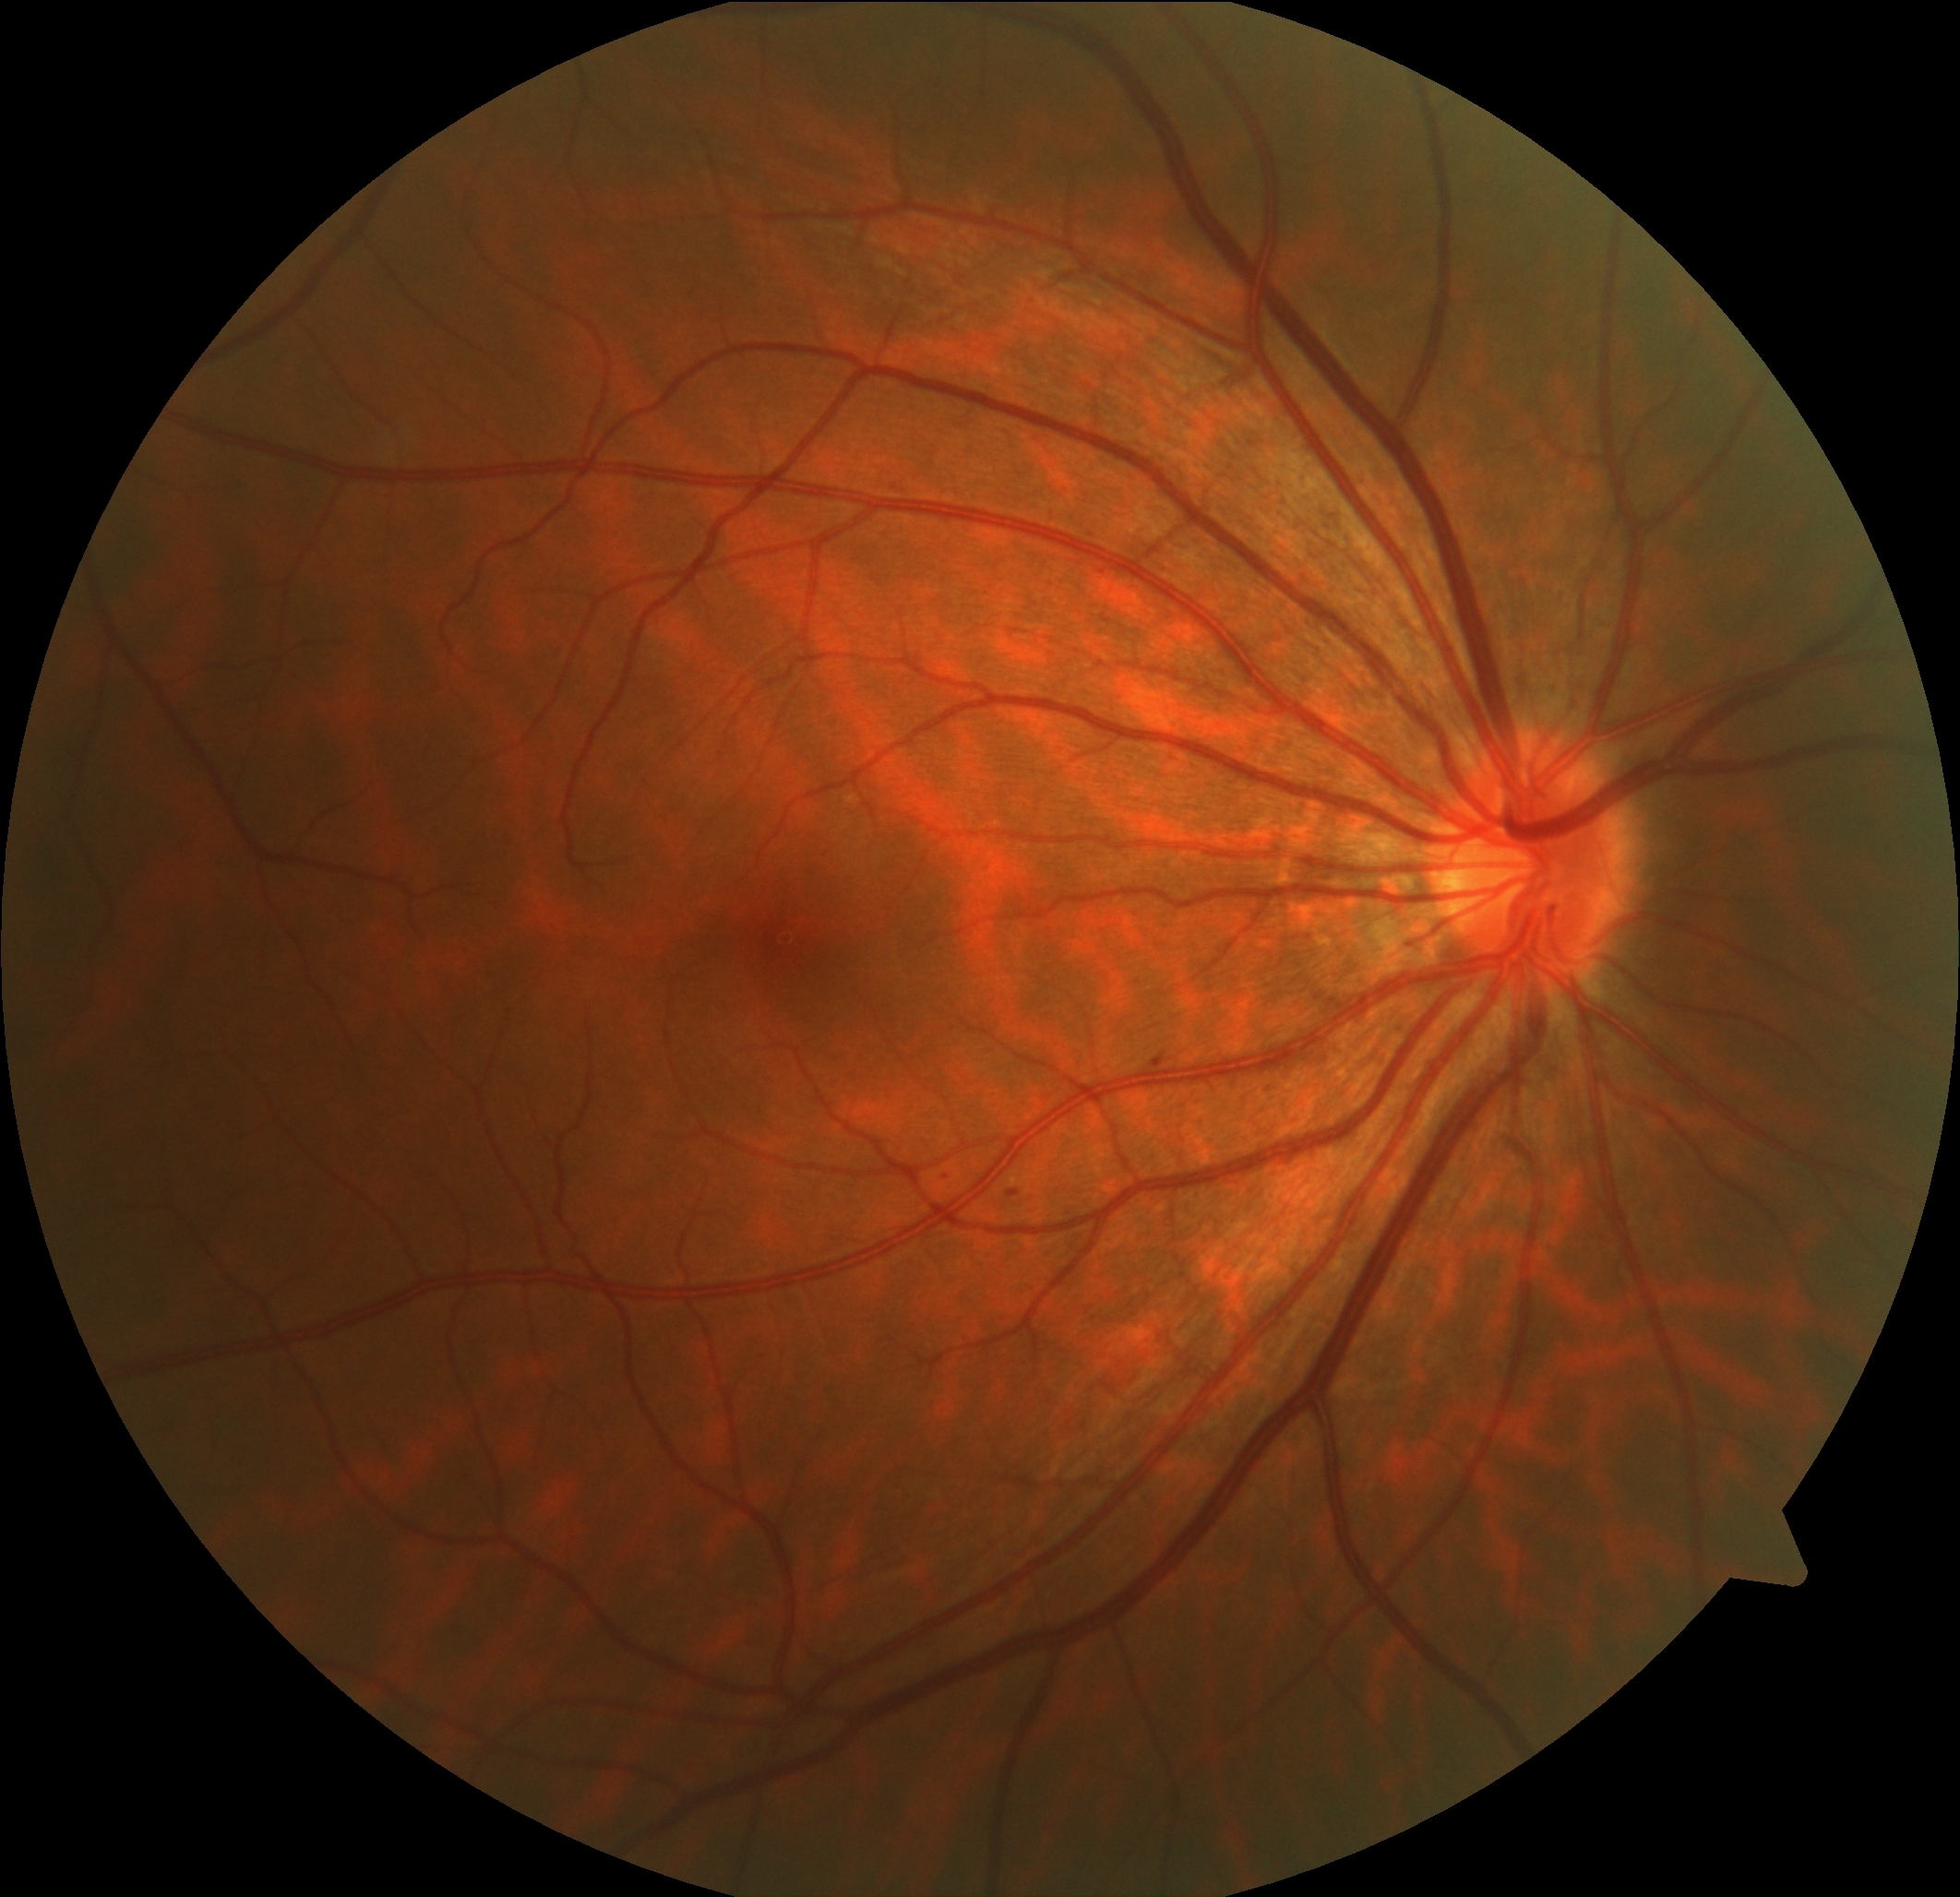 {
  "dr_category": "non-proliferative diabetic retinopathy",
  "dr_grade": "1"
}